45° FOV. 2352x1568. Fundus photo — 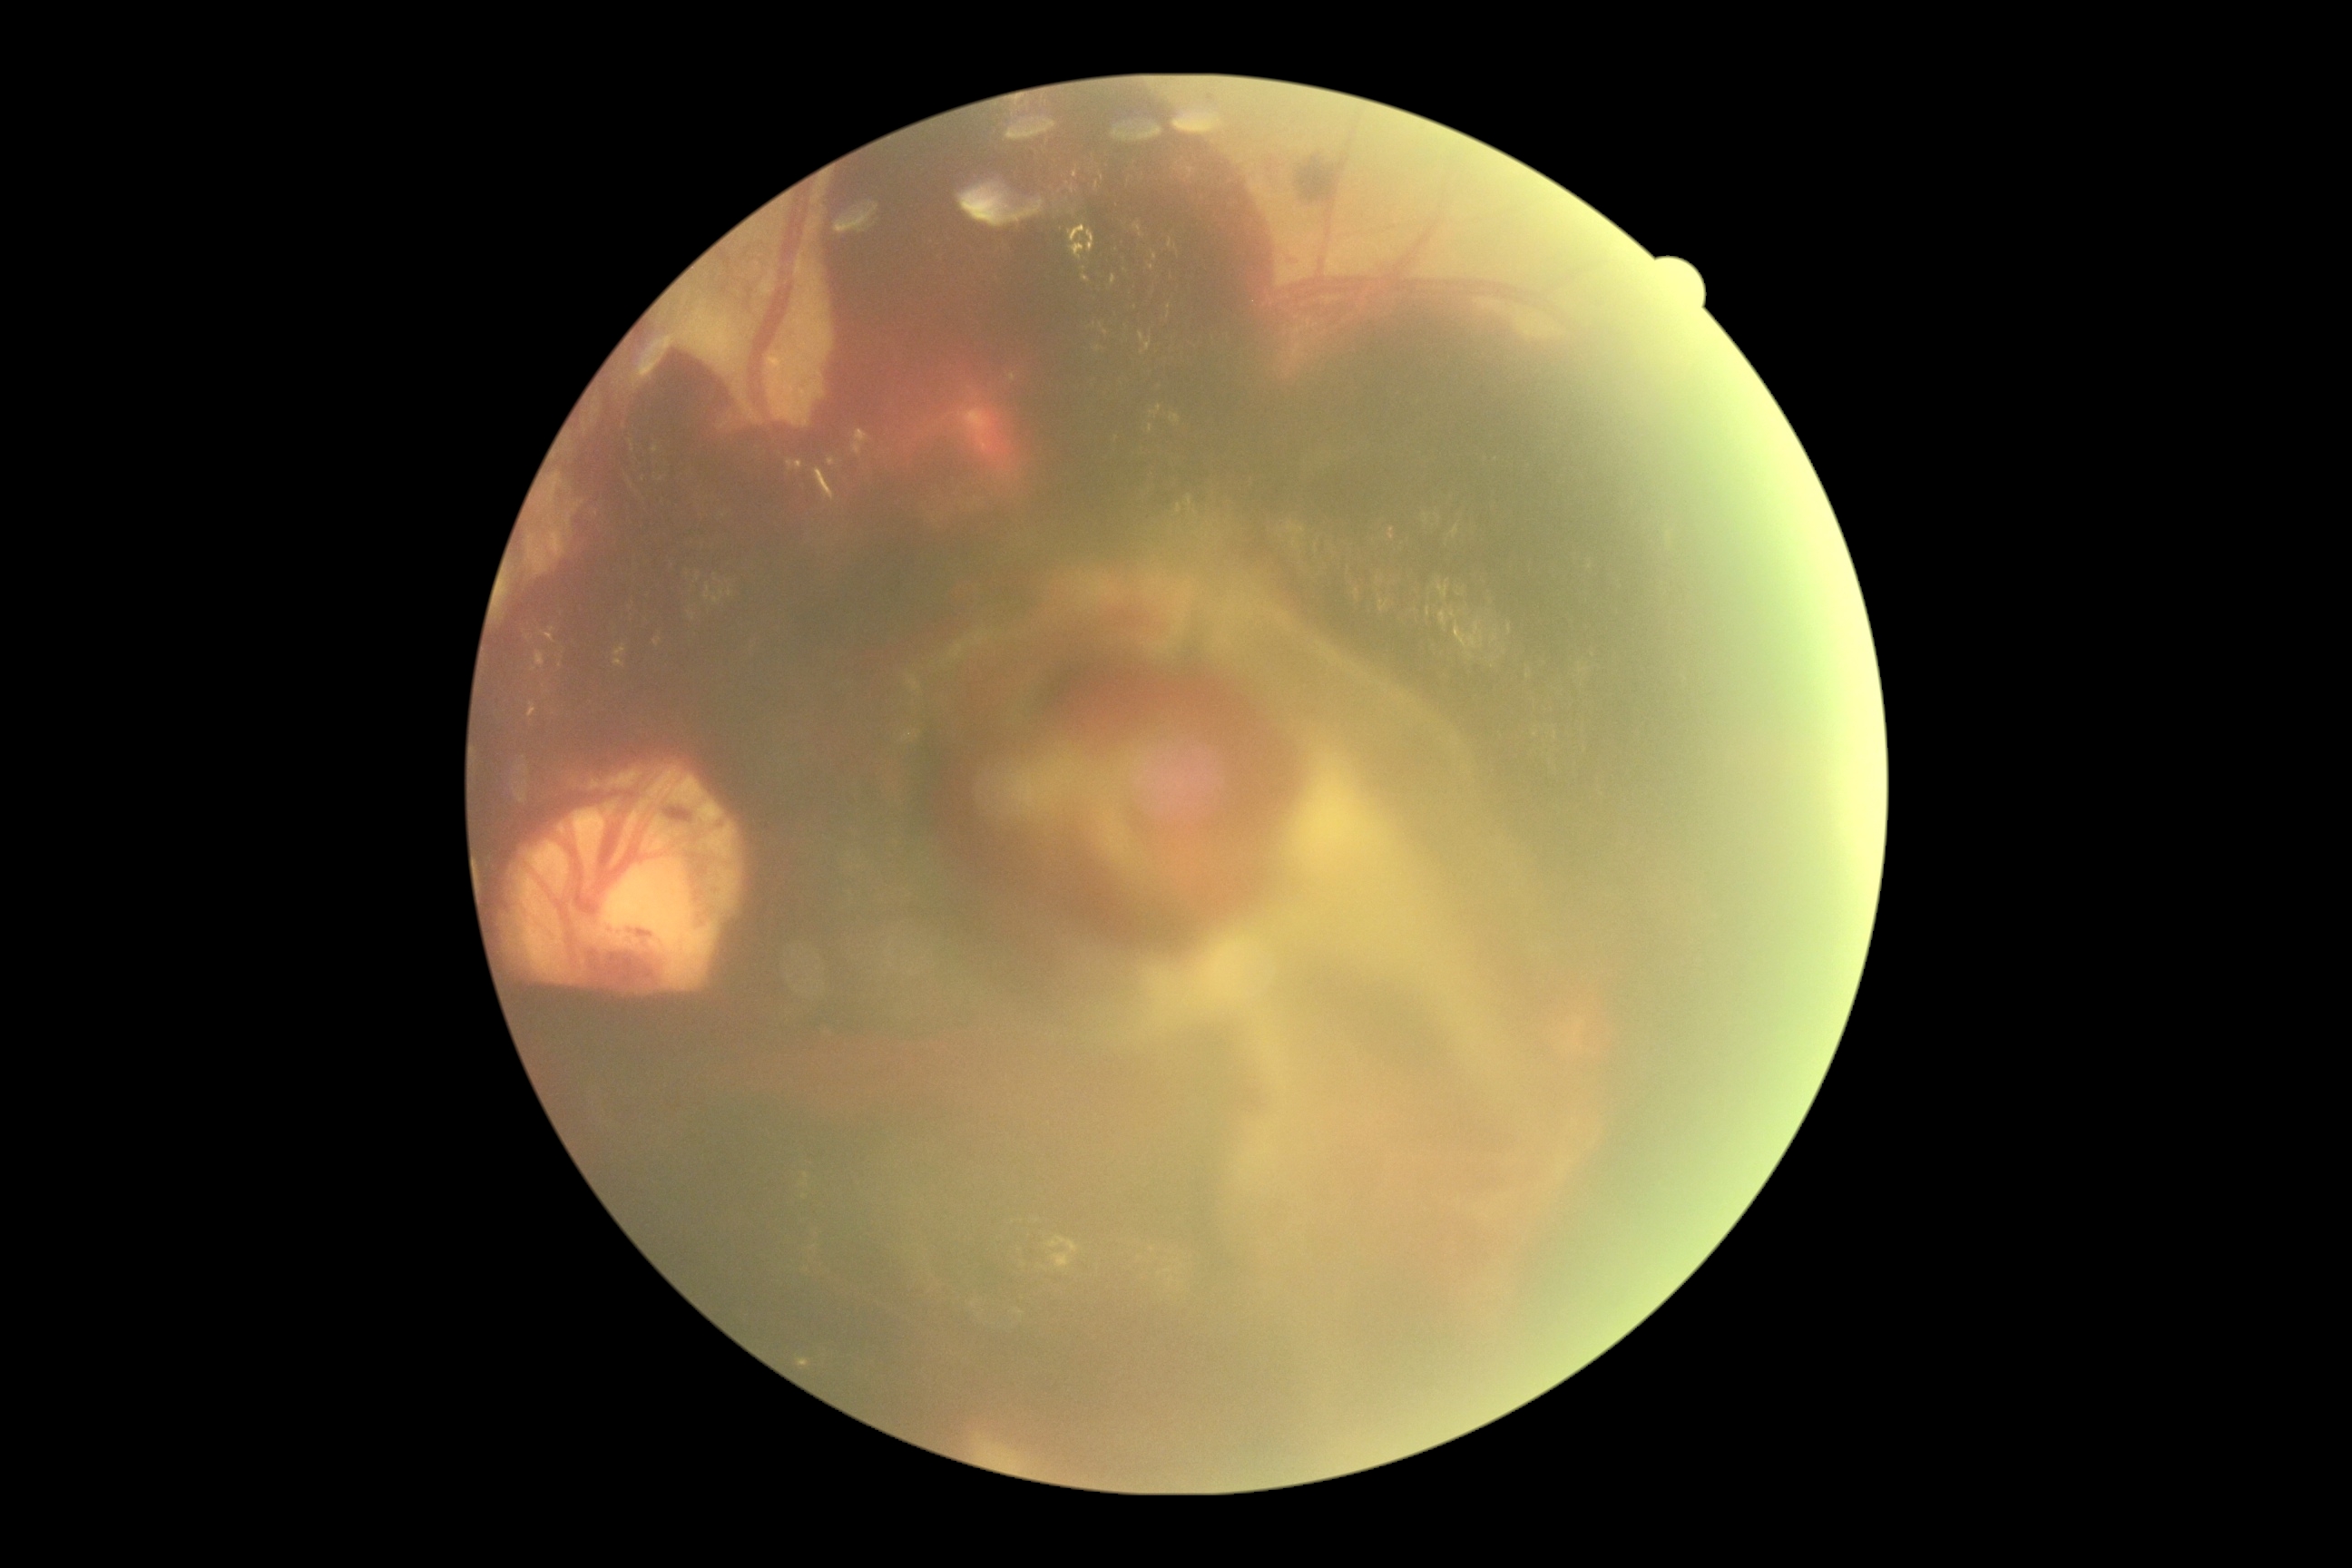

DR: grade 4.